45 degree fundus photograph; NIDEK AFC-230.
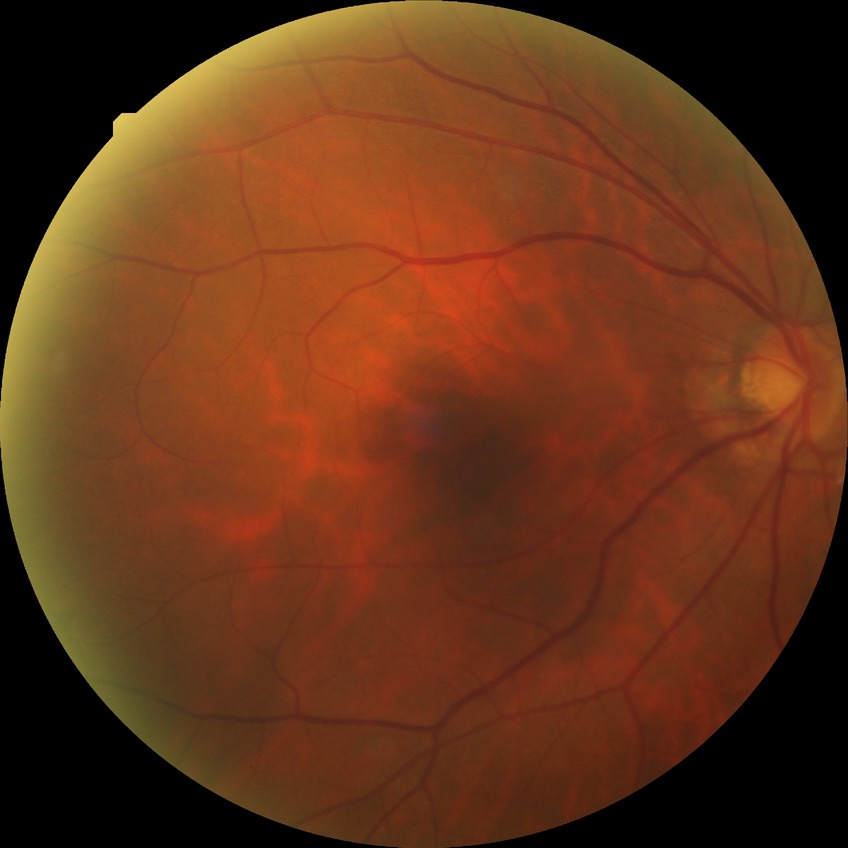
Diabetic retinopathy grade: simple diabetic retinopathy.